50-degree field of view, image size 2228x1652, color fundus photograph.
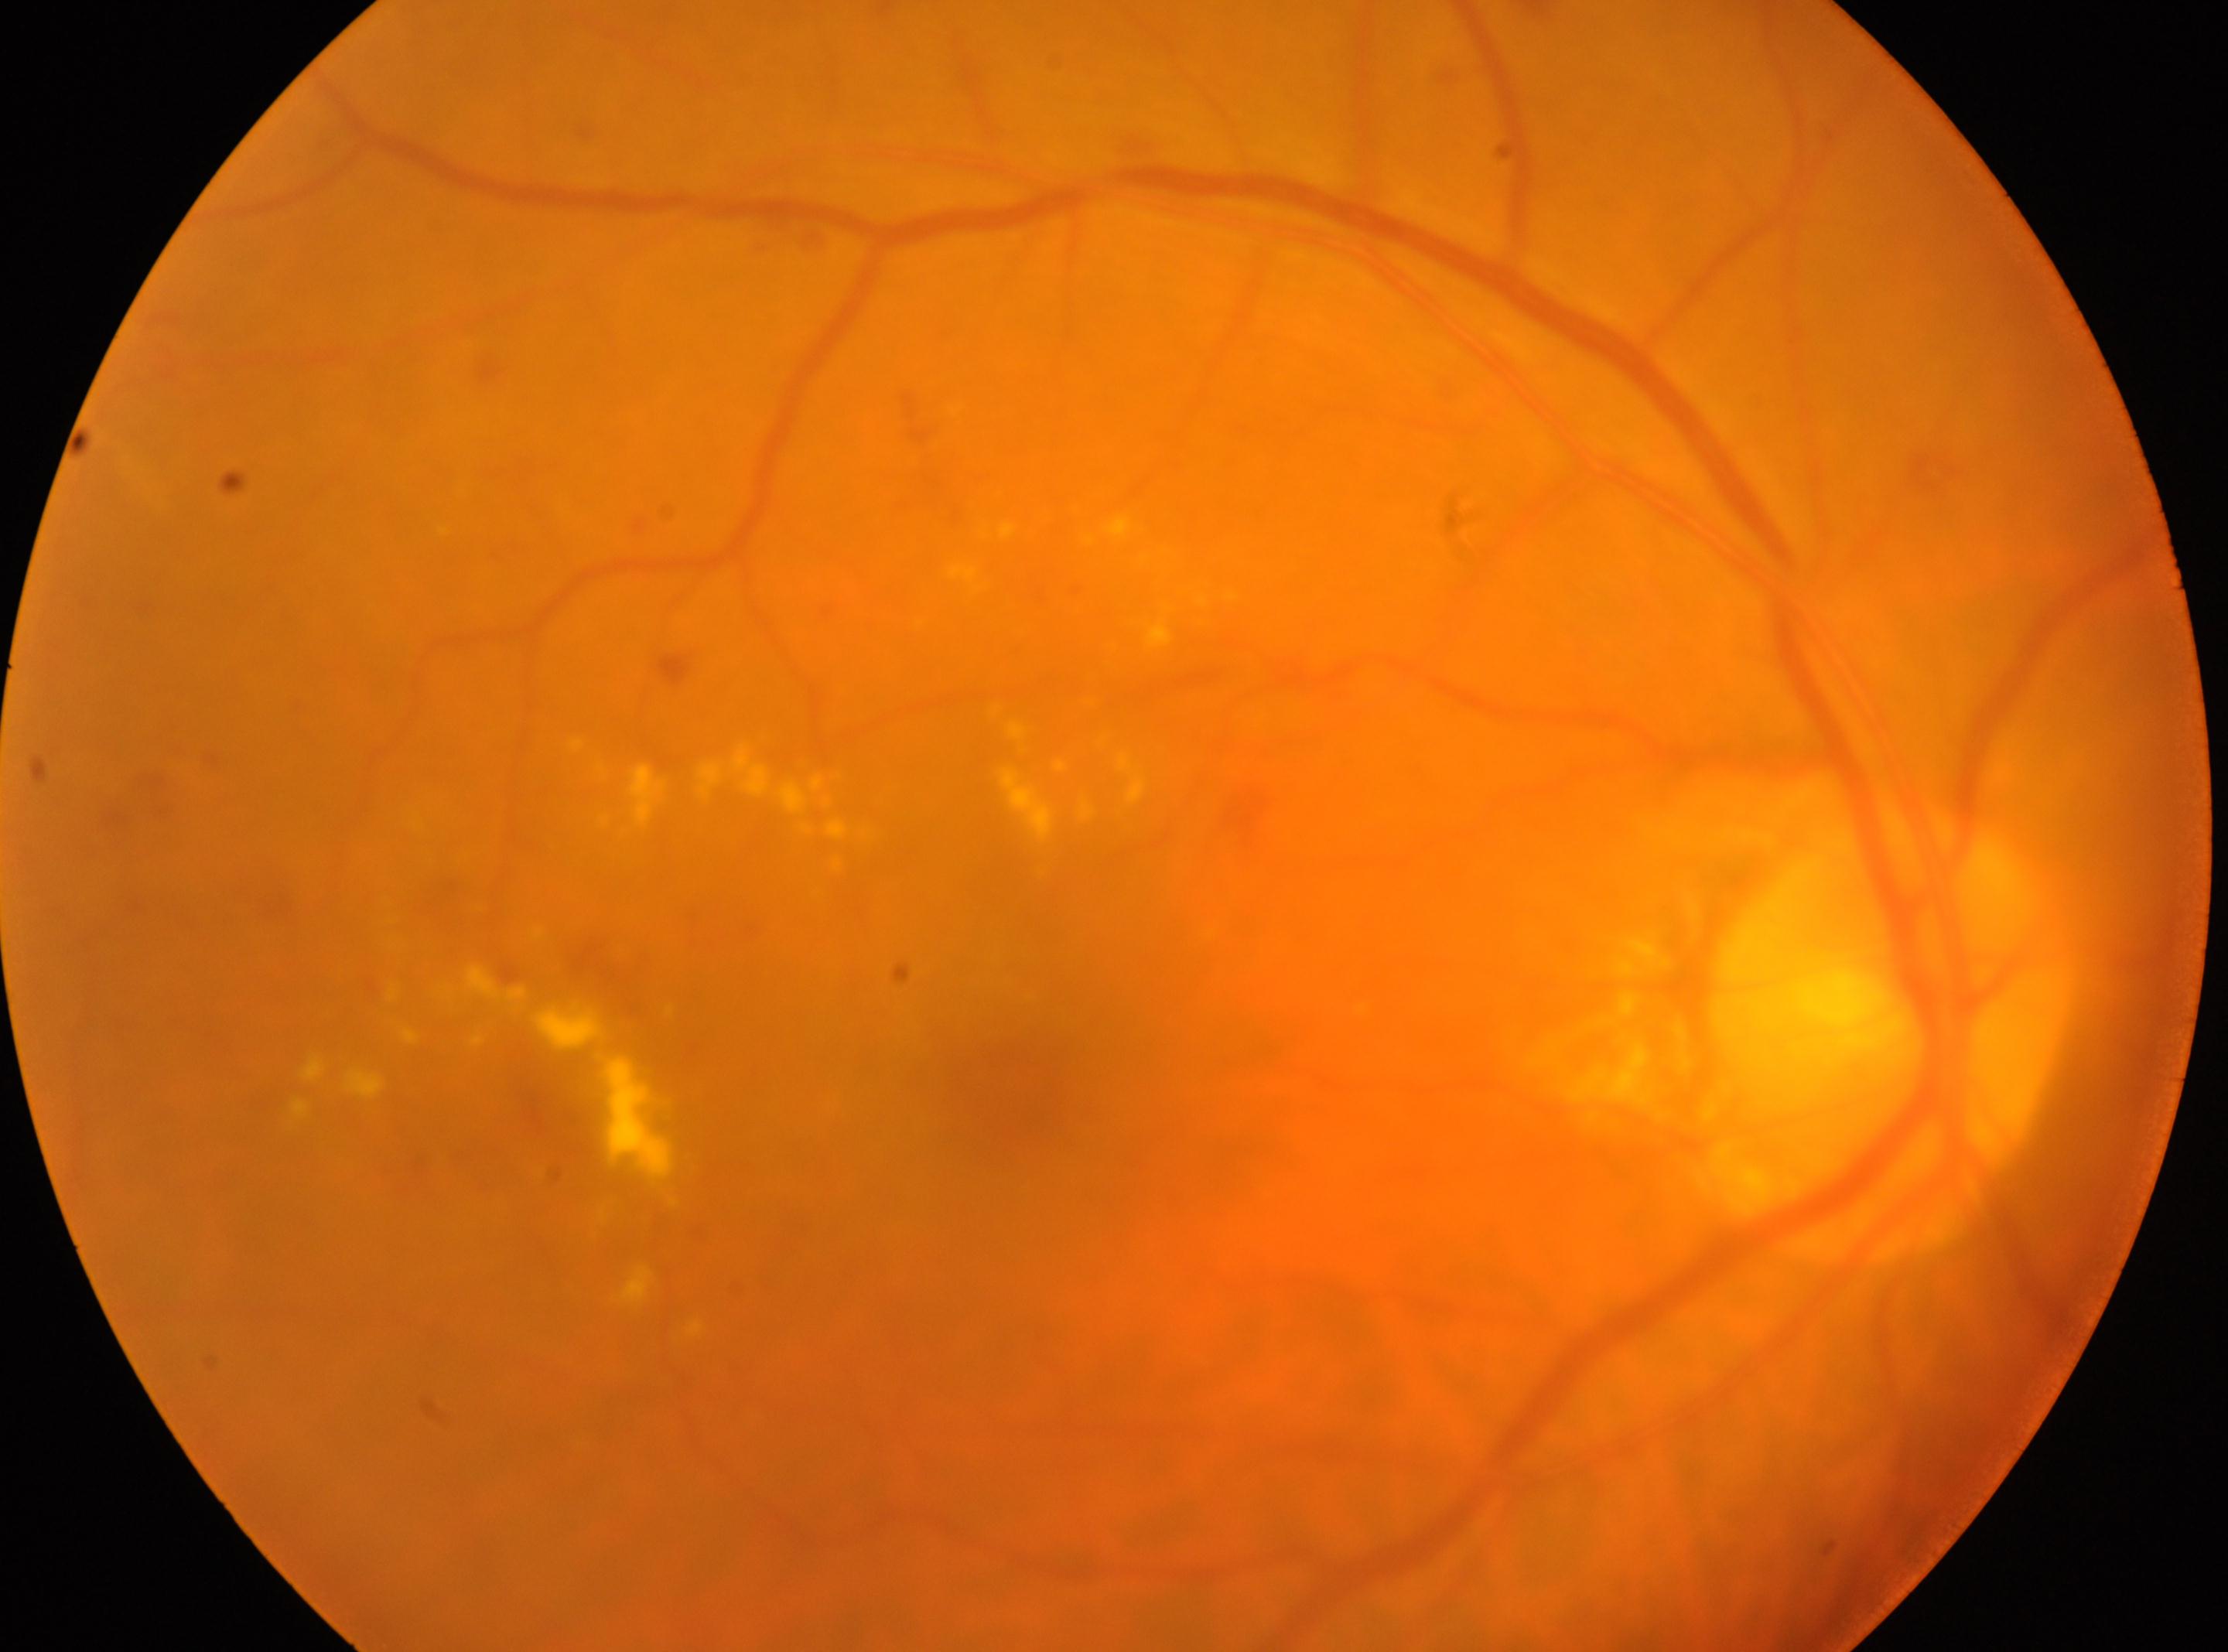
right | optic disc: x=1882, y=1032 | fovea: x=993, y=1089 | DR grade: moderate NPDR (2).